Optic disc-centered crop; camera: Nidek AFC-330; color fundus image:
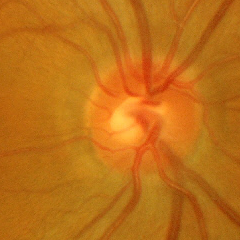

There is evidence of no glaucoma.